45° FOV · retinal fundus photograph:
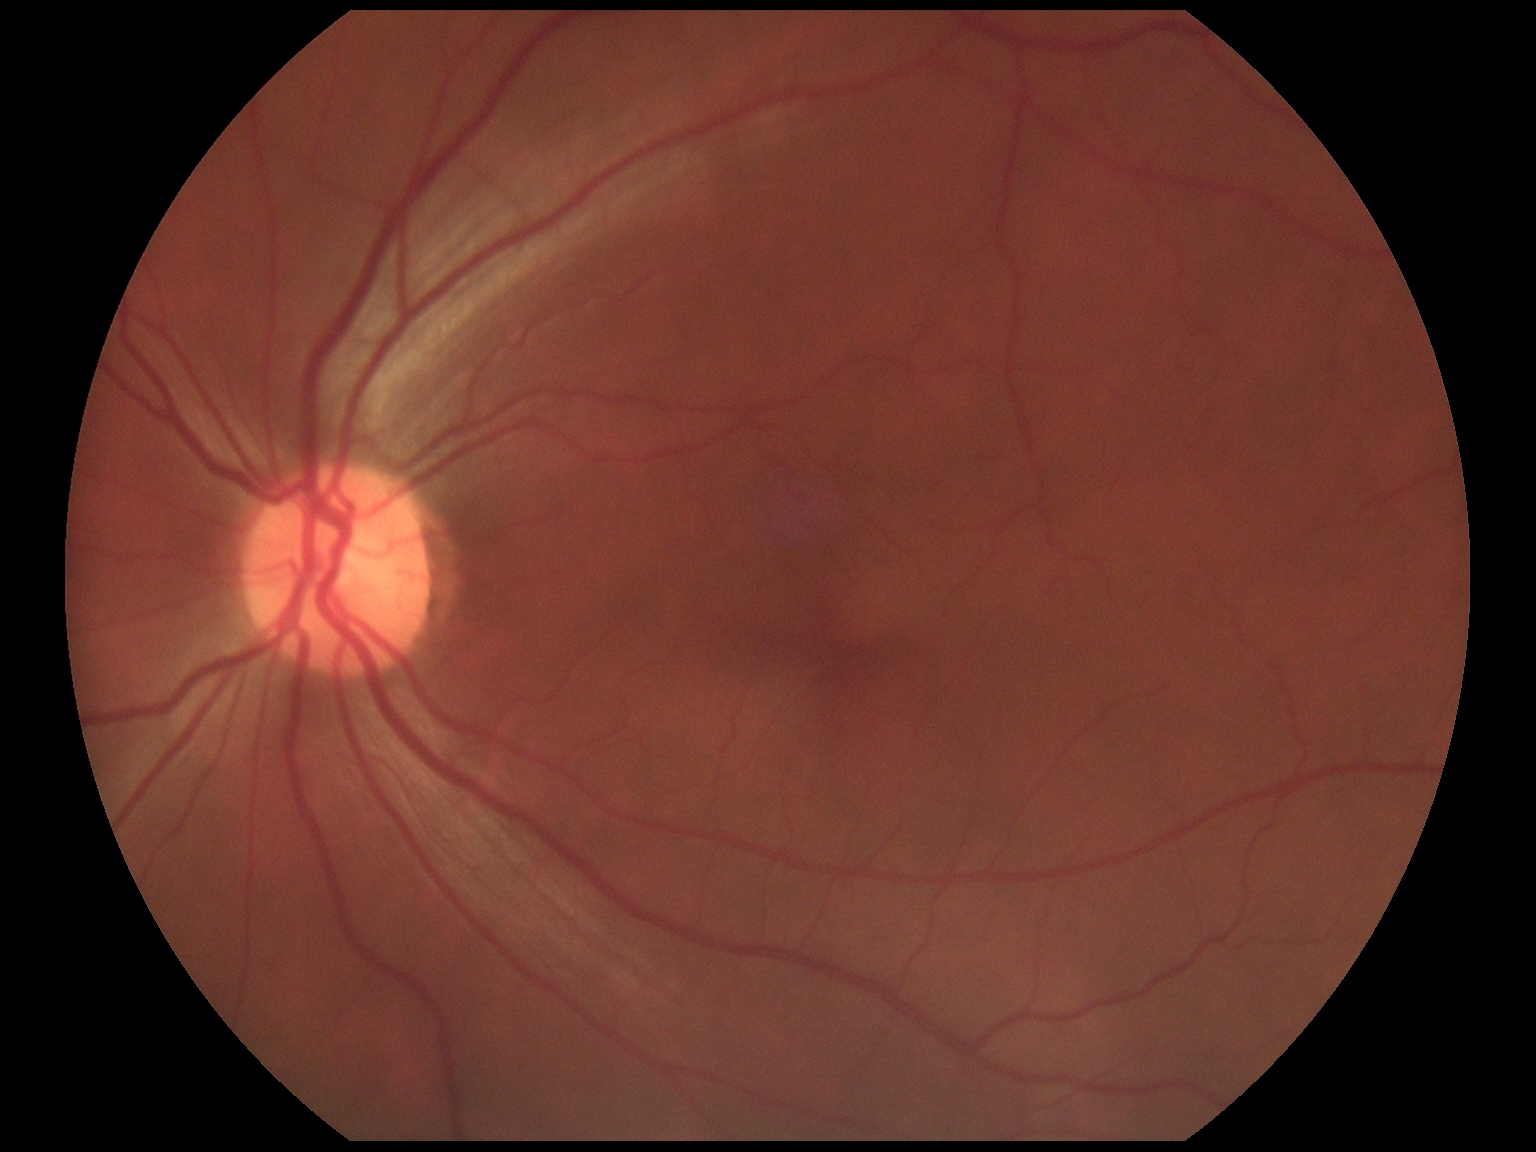

Retinopathy is grade 0 (no apparent retinopathy).